Color fundus image. 45° field of view. 2352x1568px.
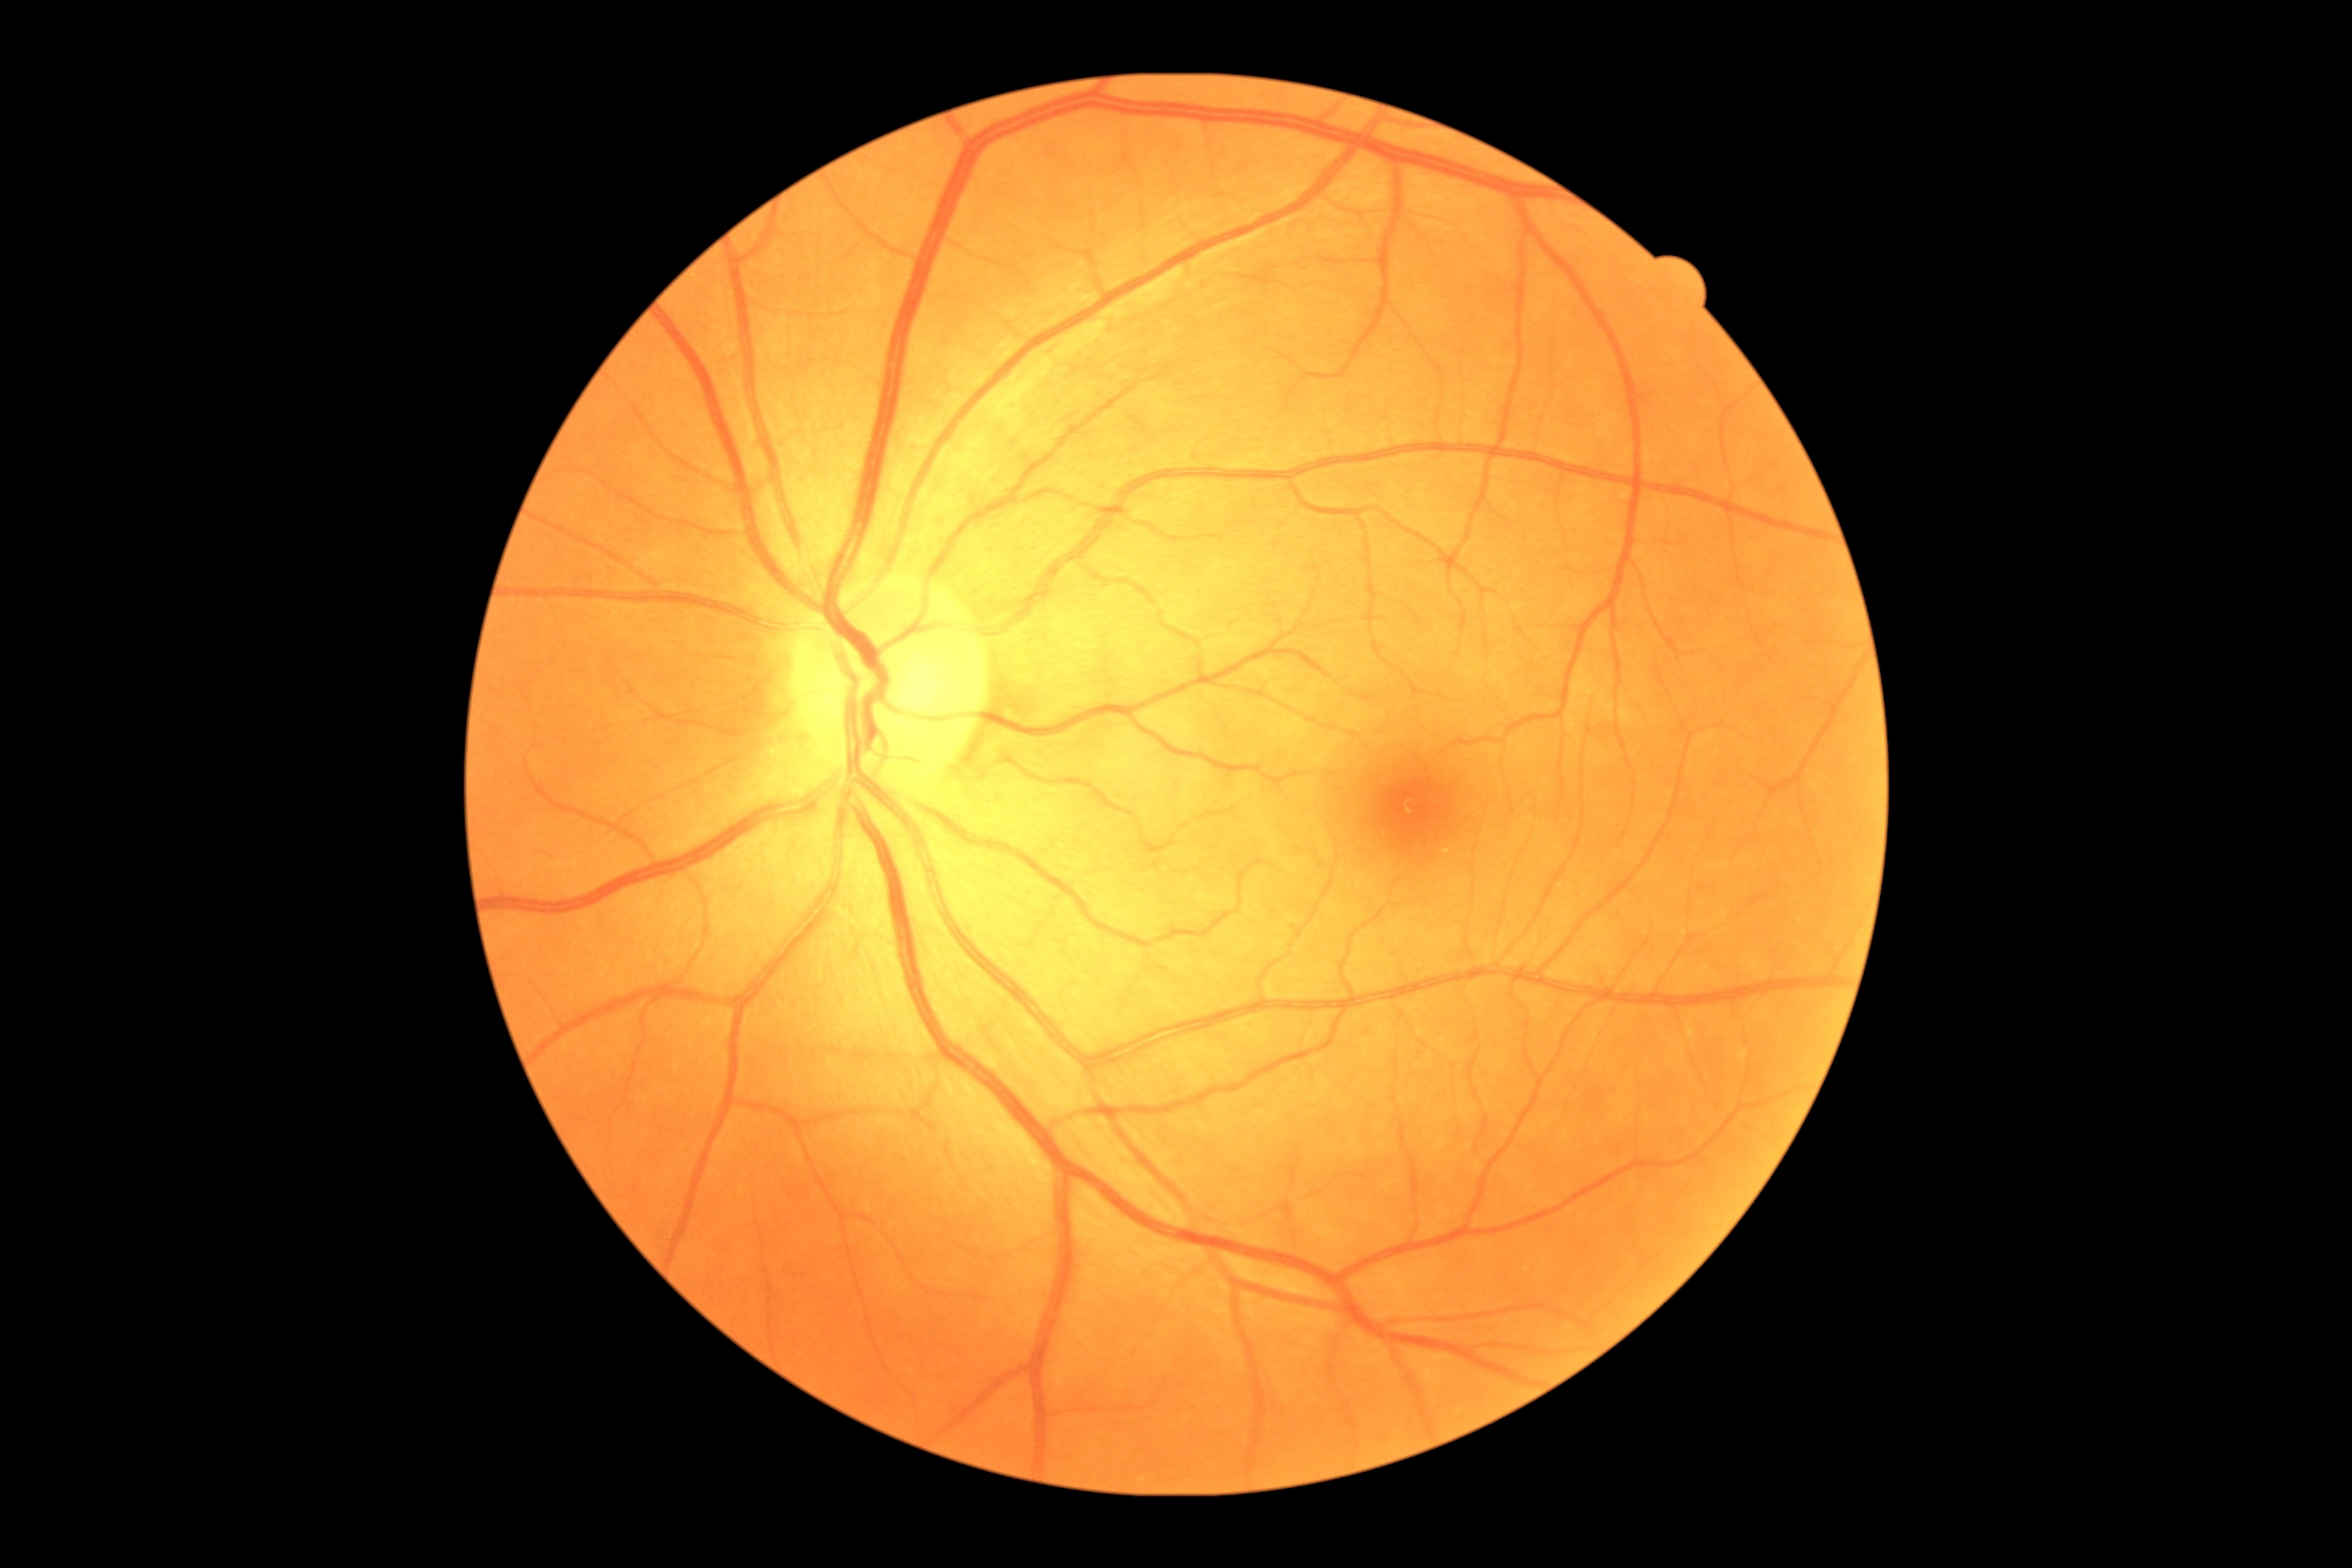
Annotations:
• DR impression — no signs of DR
• DR stage — grade 0 (no apparent retinopathy)